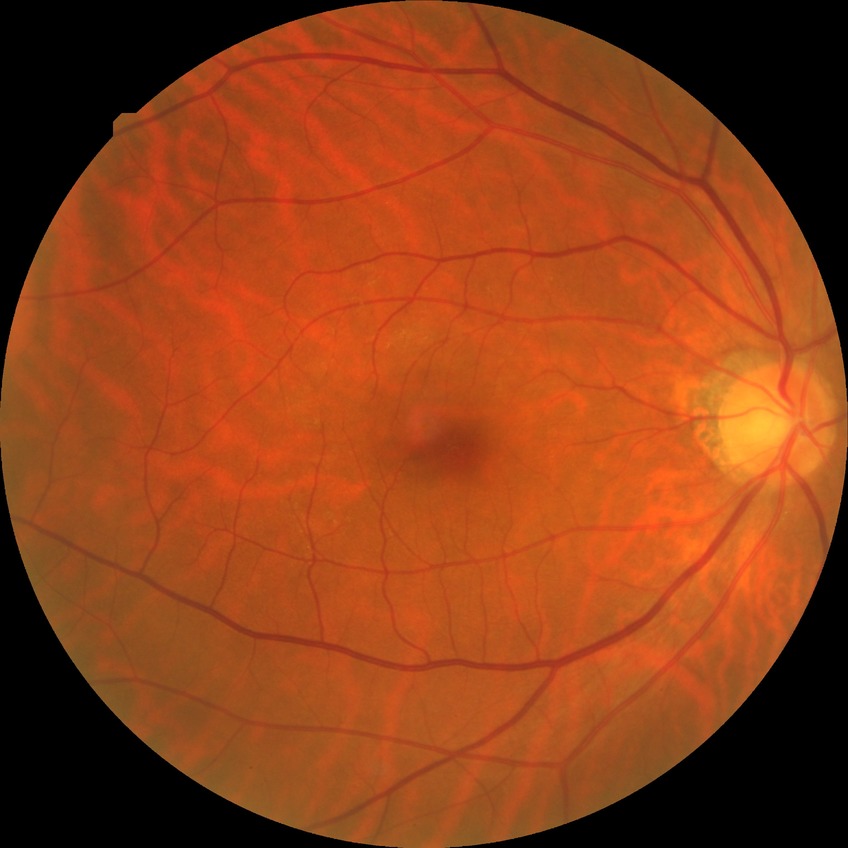 davis_grade: NDR
dr_impression: no DR findings